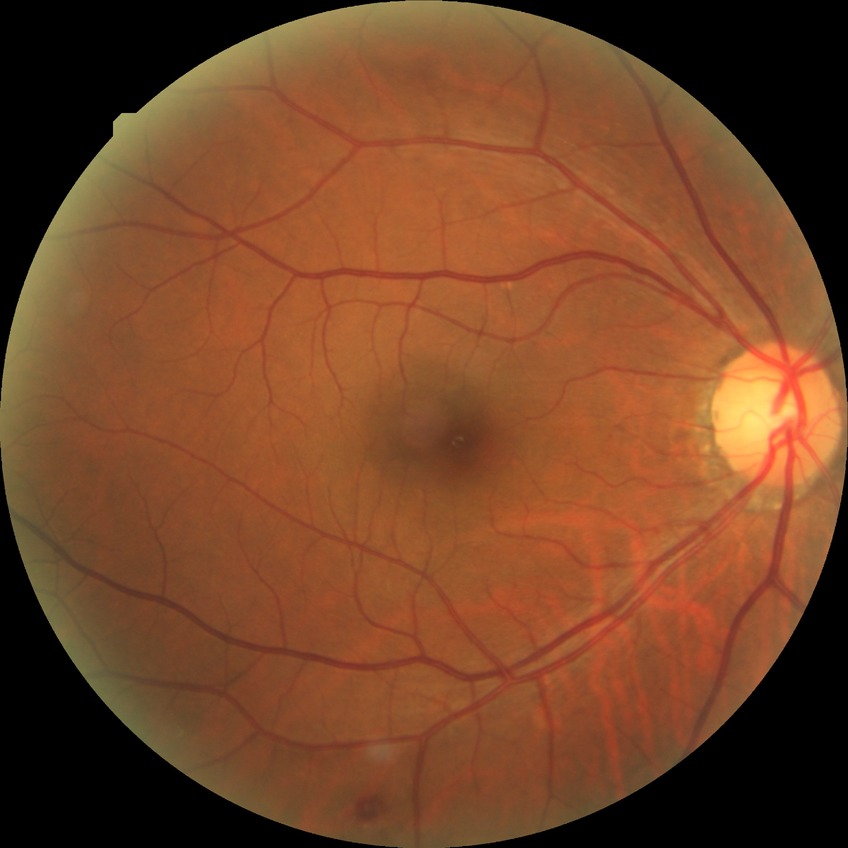
{"proliferative_class": "non-proliferative diabetic retinopathy", "davis_grade": "simple diabetic retinopathy (SDR)"}